Color fundus photograph from a handheld portable camera:
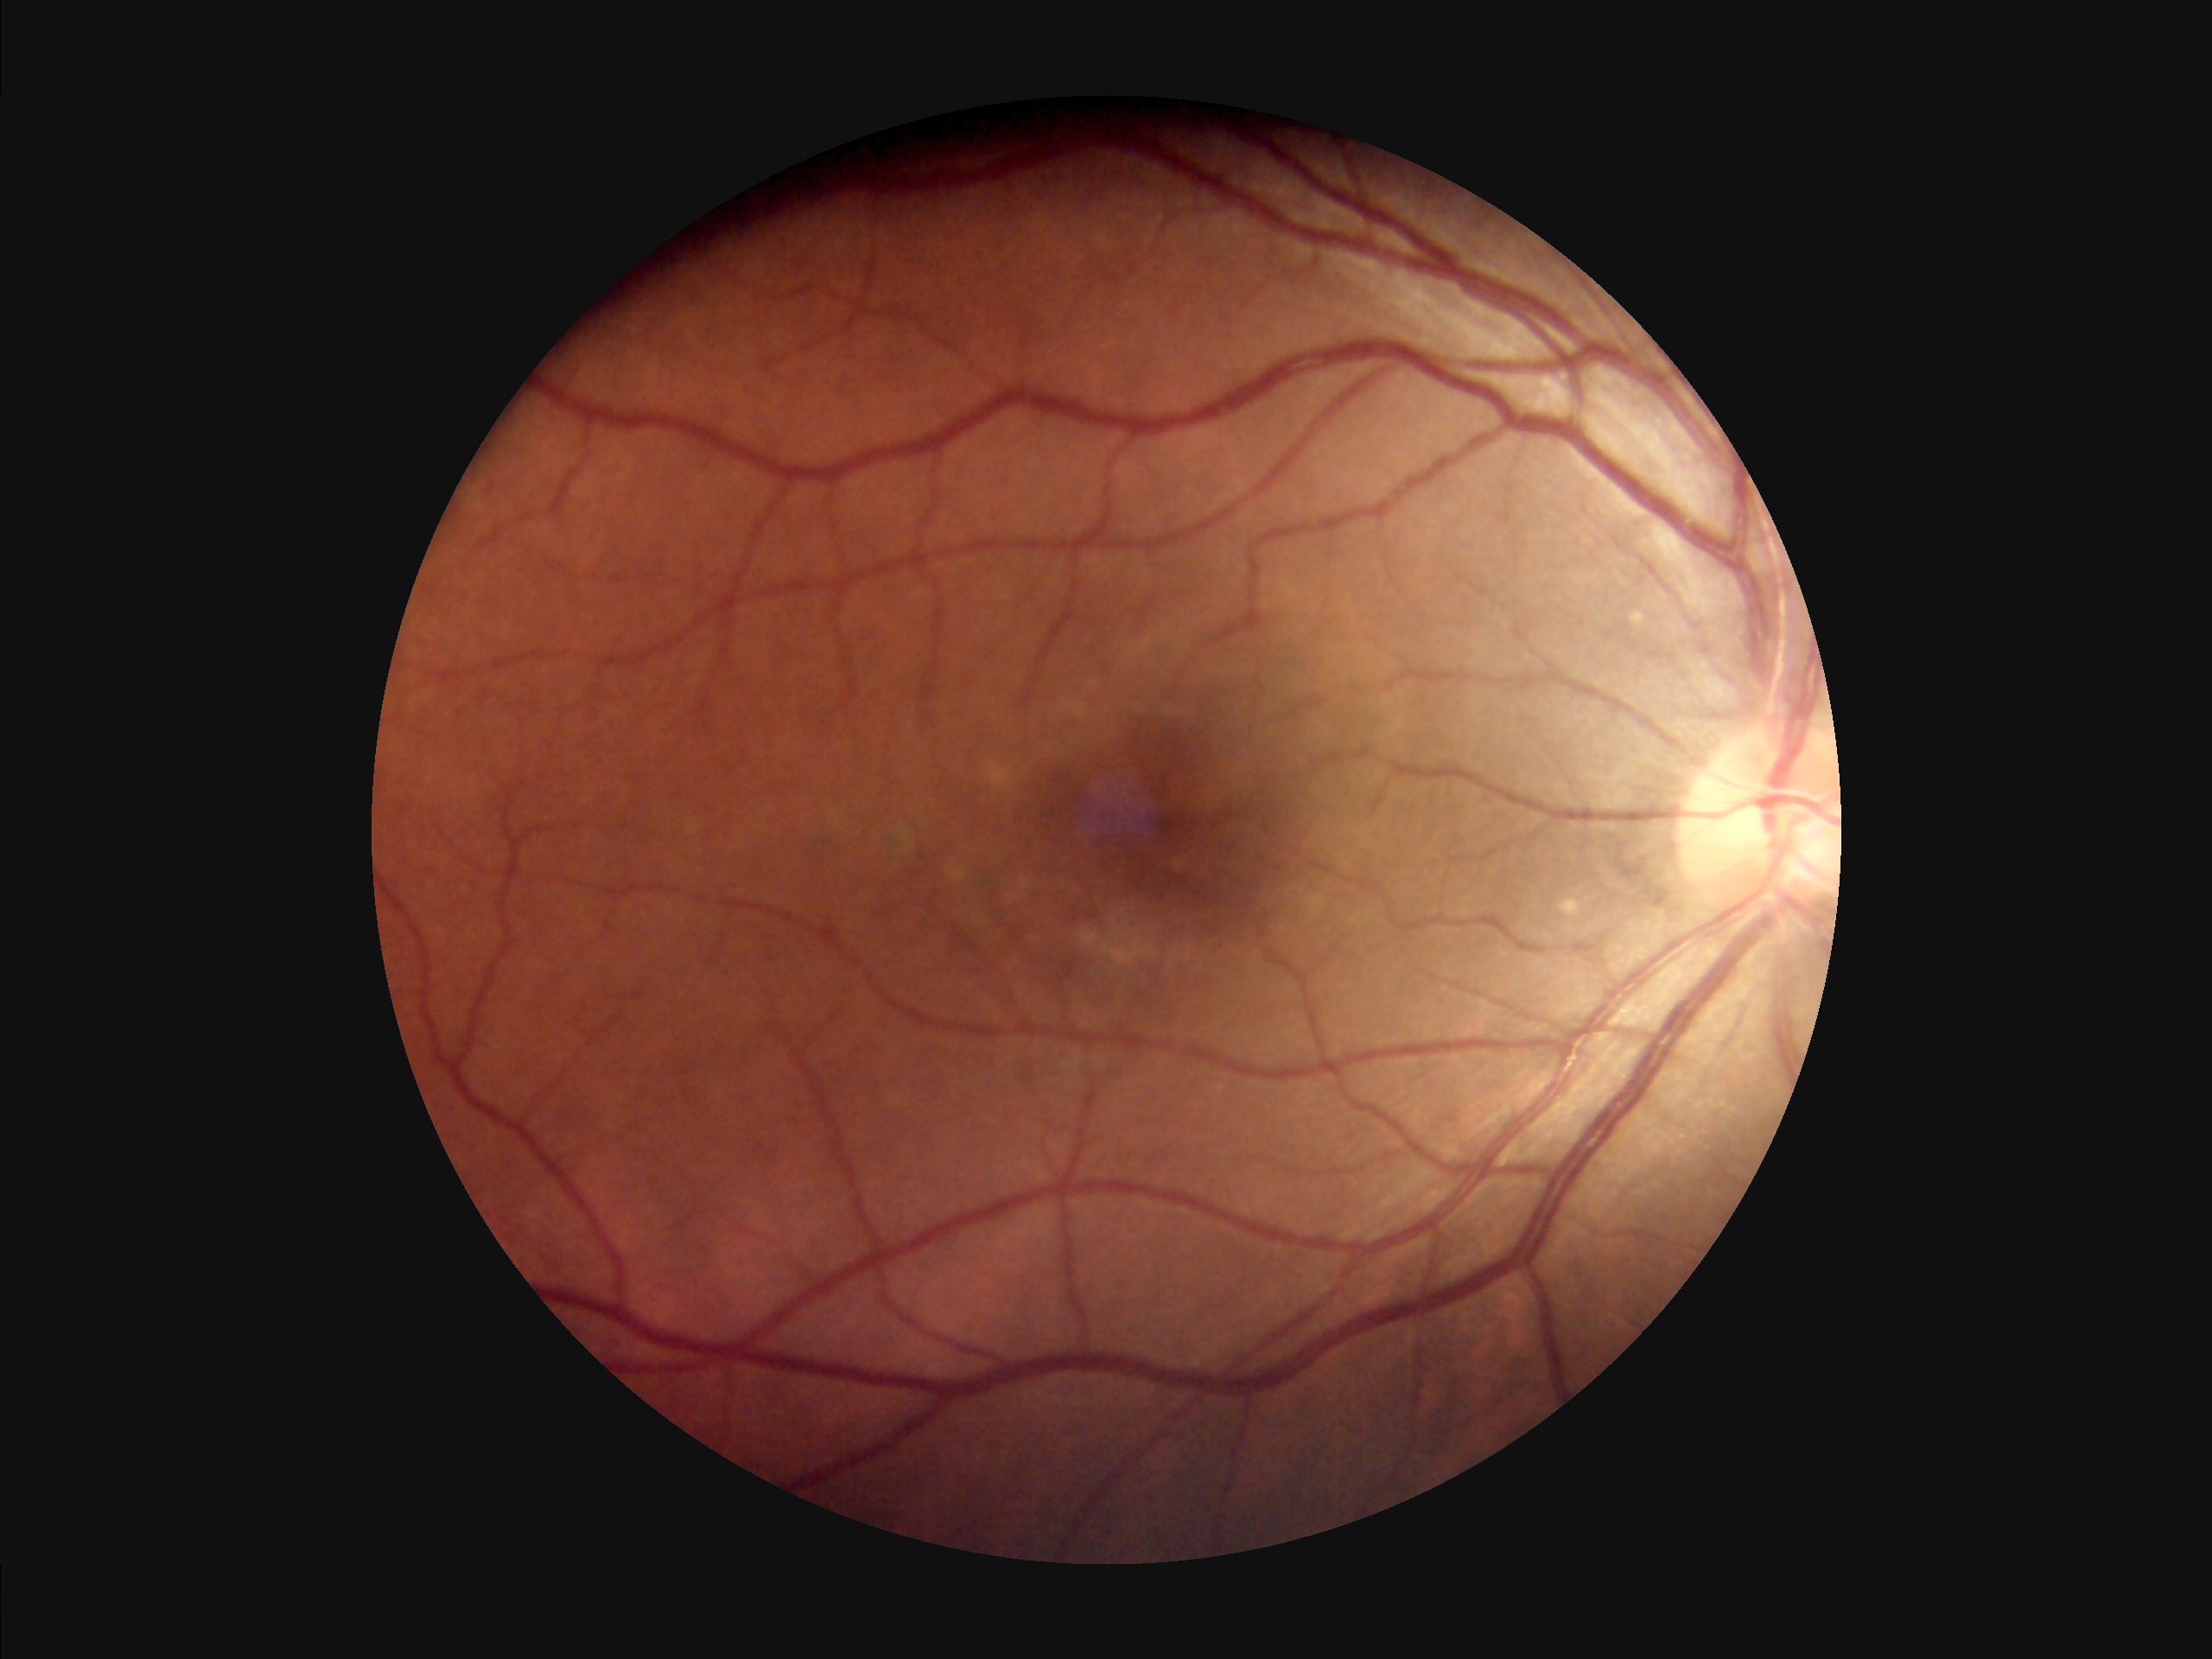 Overall quality: acceptable
Illumination: good
Contrast: good
Sharpness: in focus